45-degree field of view: 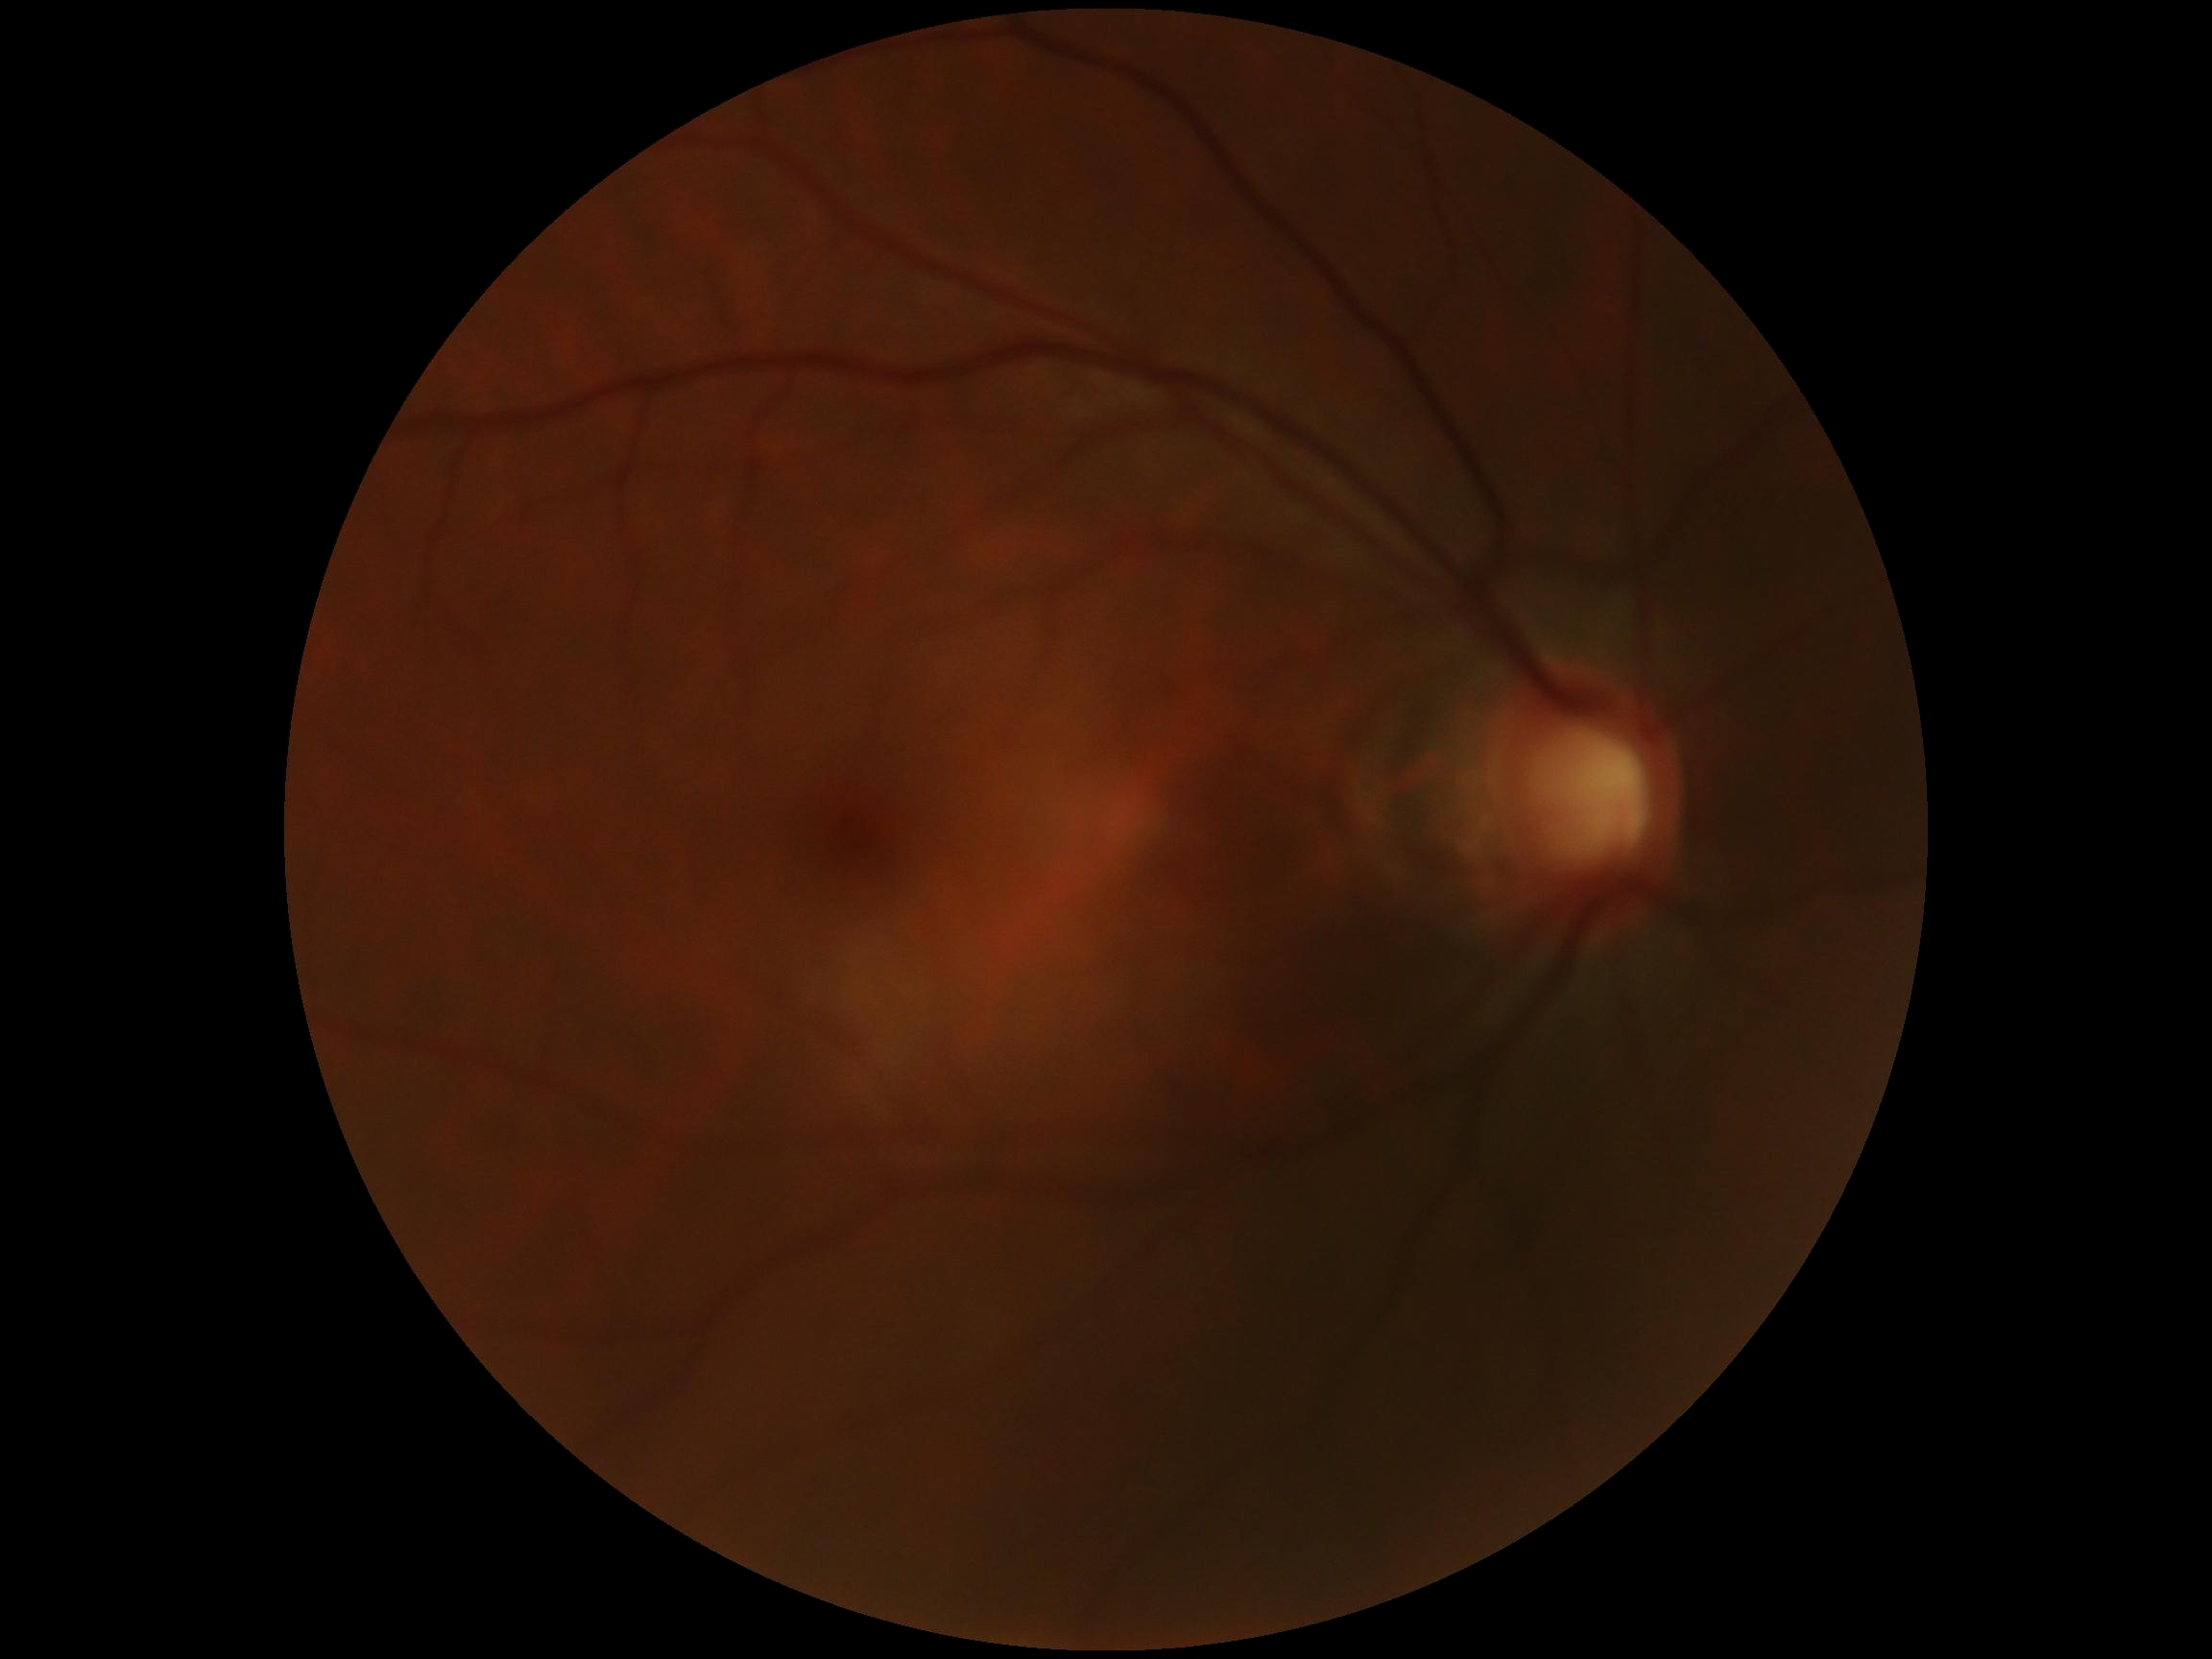
DR impression: negative for DR, DR grade: no apparent diabetic retinopathy (0).